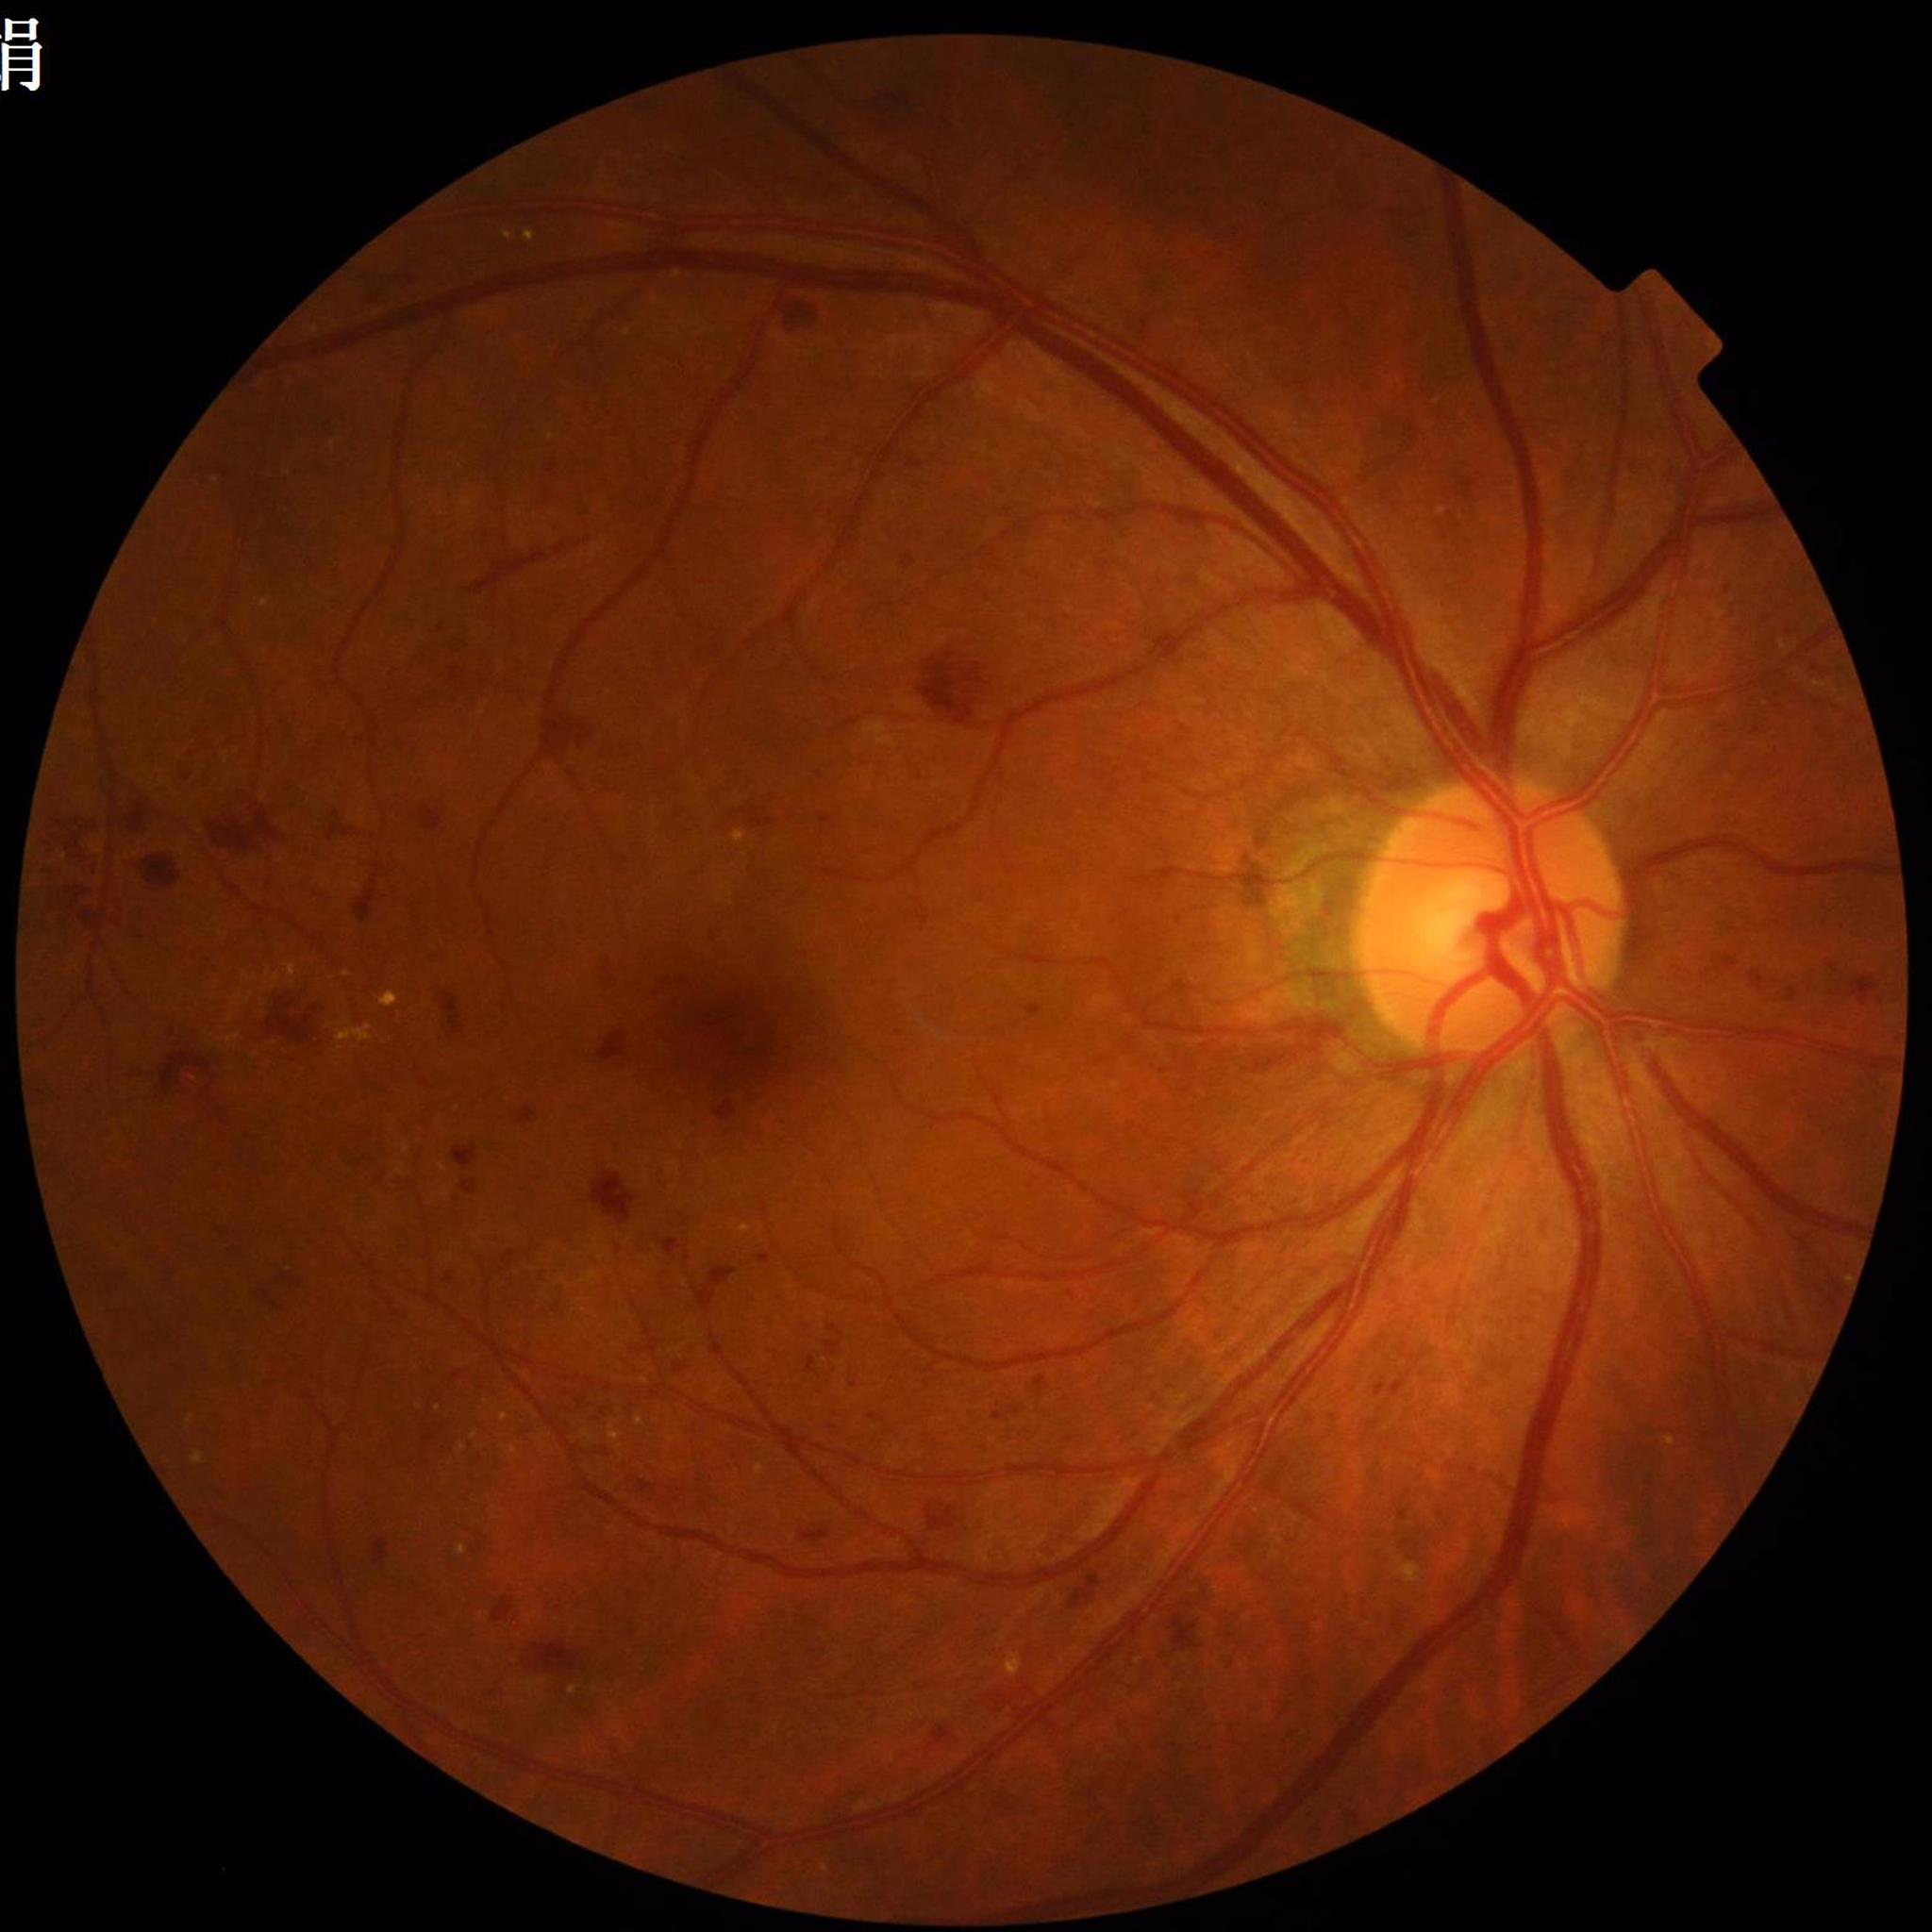 Diagnosis = diabetic retinopathy (DR).